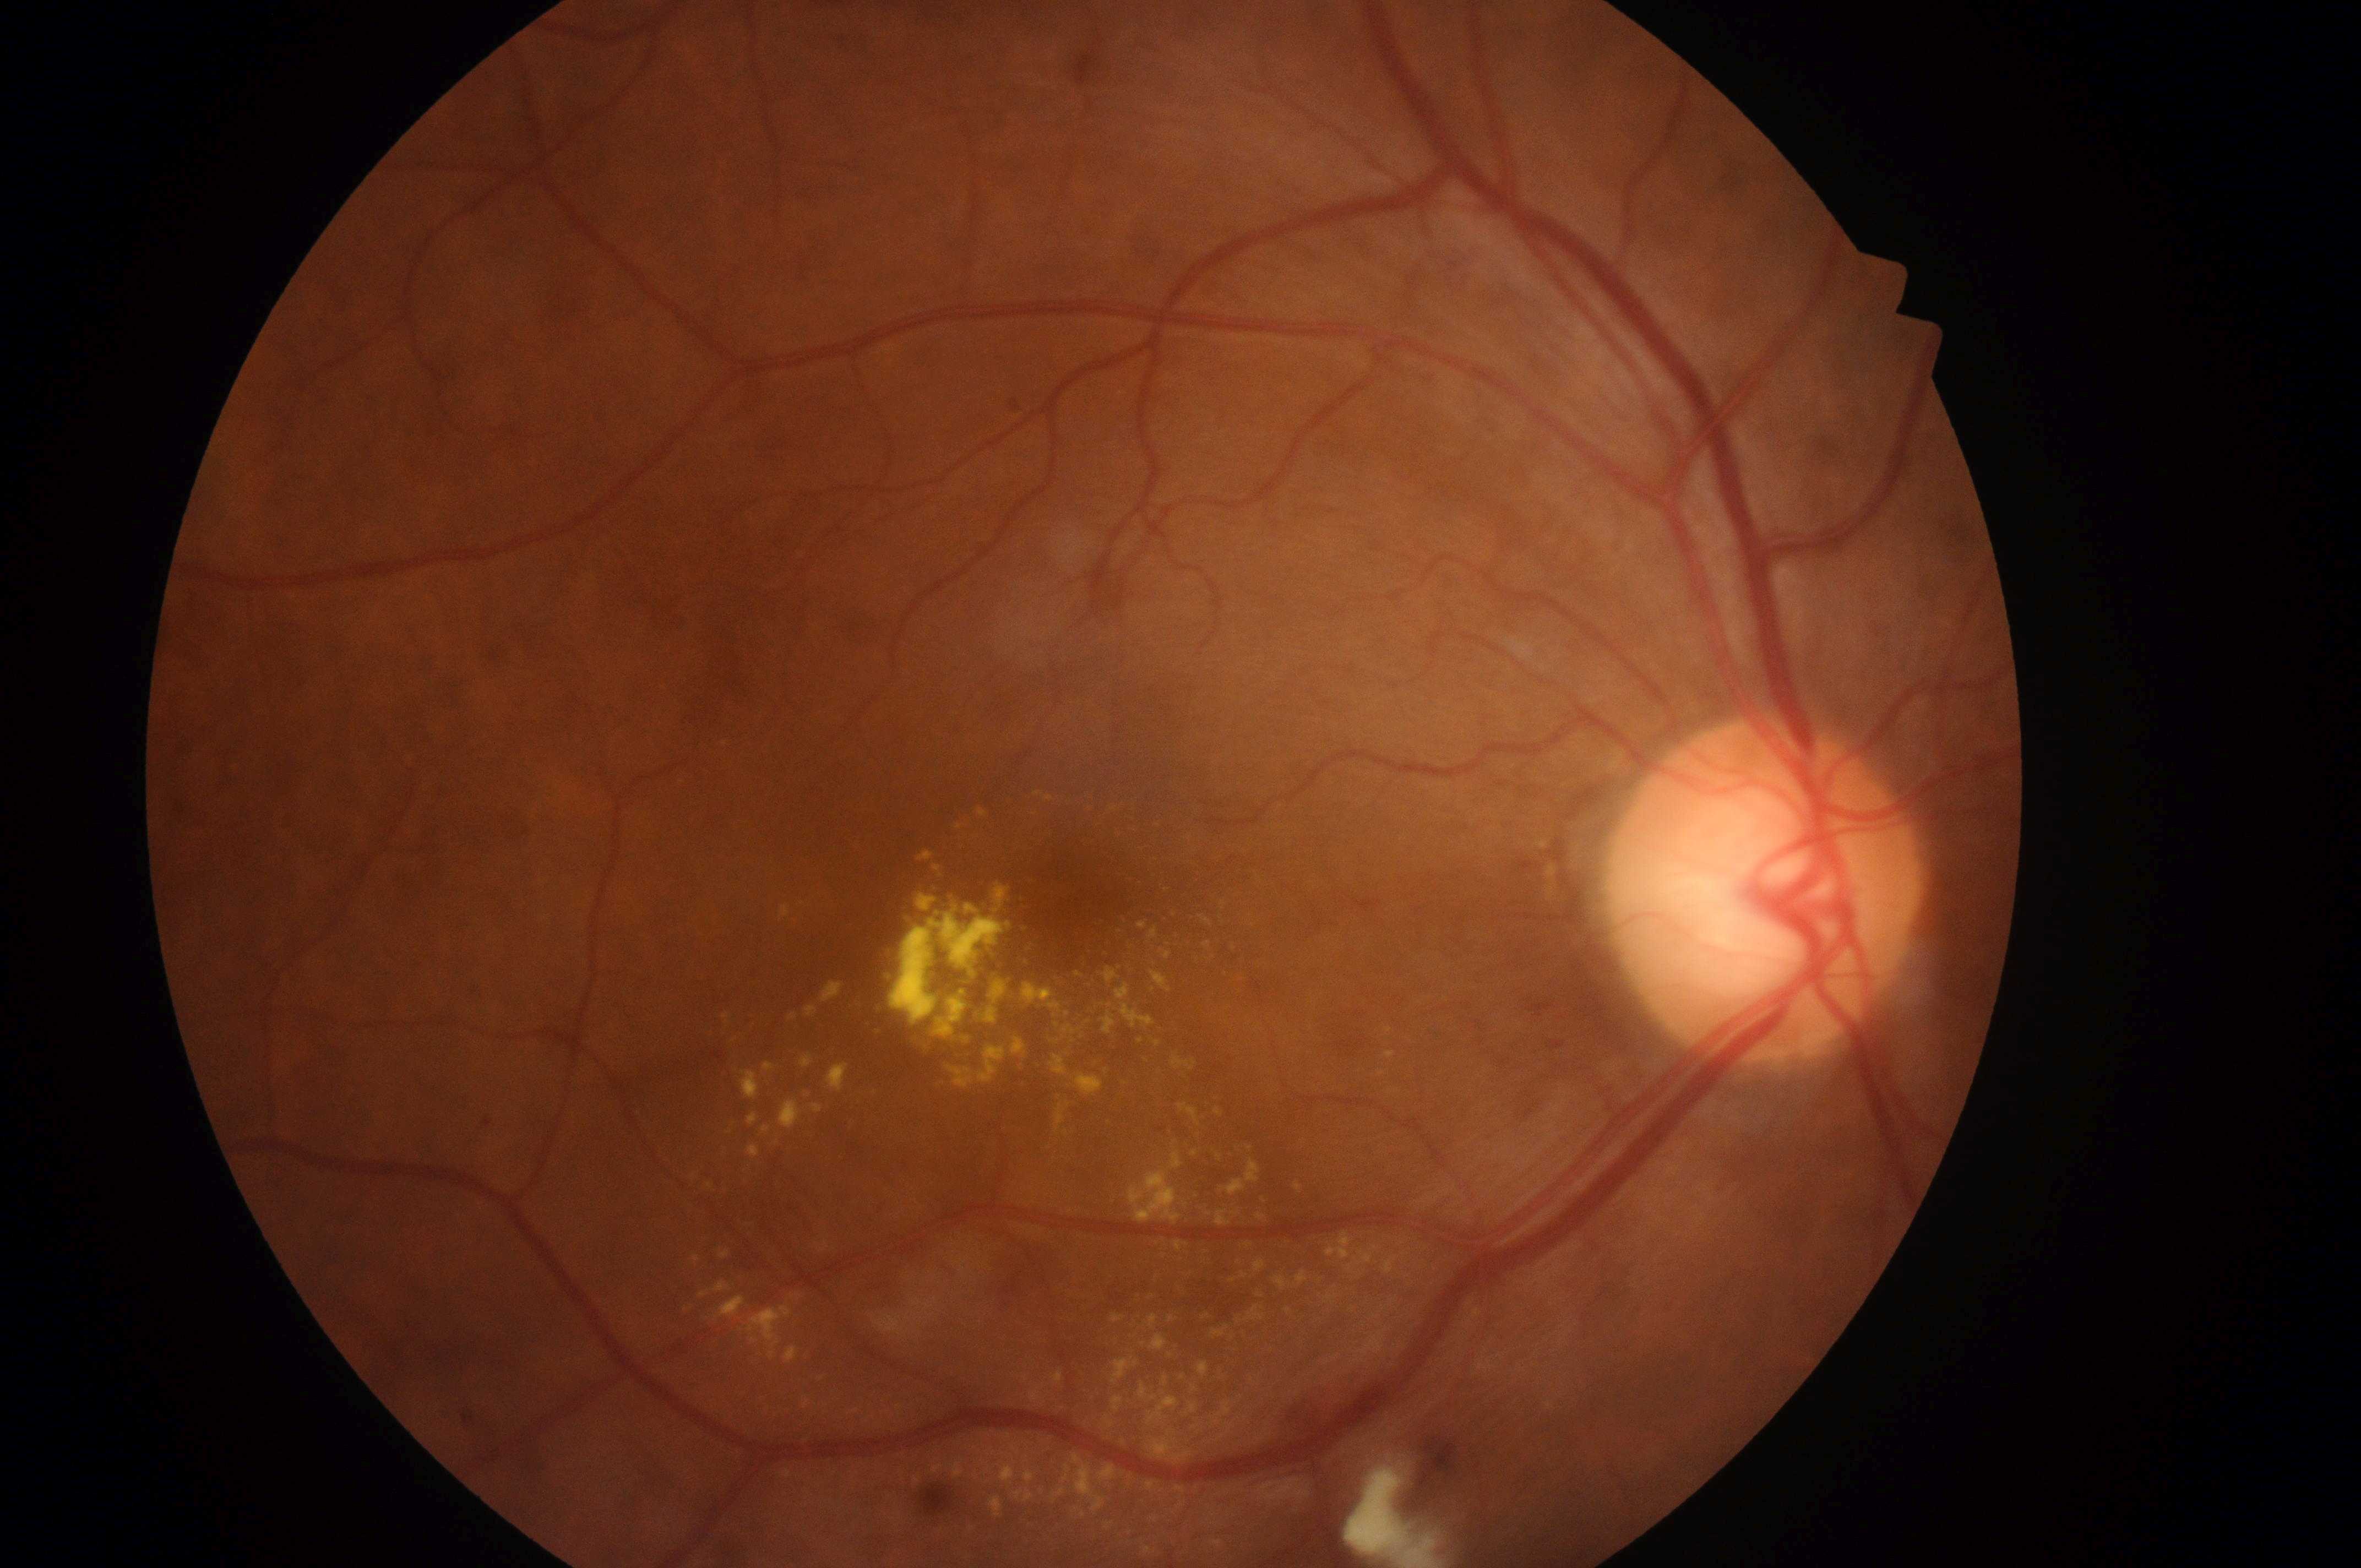

Q: What is the DME risk grade?
A: grade 2 (high risk) — hard exudates within one disc diameter of the macula center
Q: Diabetic retinopathy severity?
A: grade 2 (moderate NPDR) — more than just microaneurysms but less than severe NPDR
Q: What is the laterality?
A: right eye
Q: Fovea center?
A: (x=1081, y=890)
Q: What disease class is present?
A: non-proliferative diabetic retinopathy
Q: Locate the optic disc.
A: (x=1761, y=905)